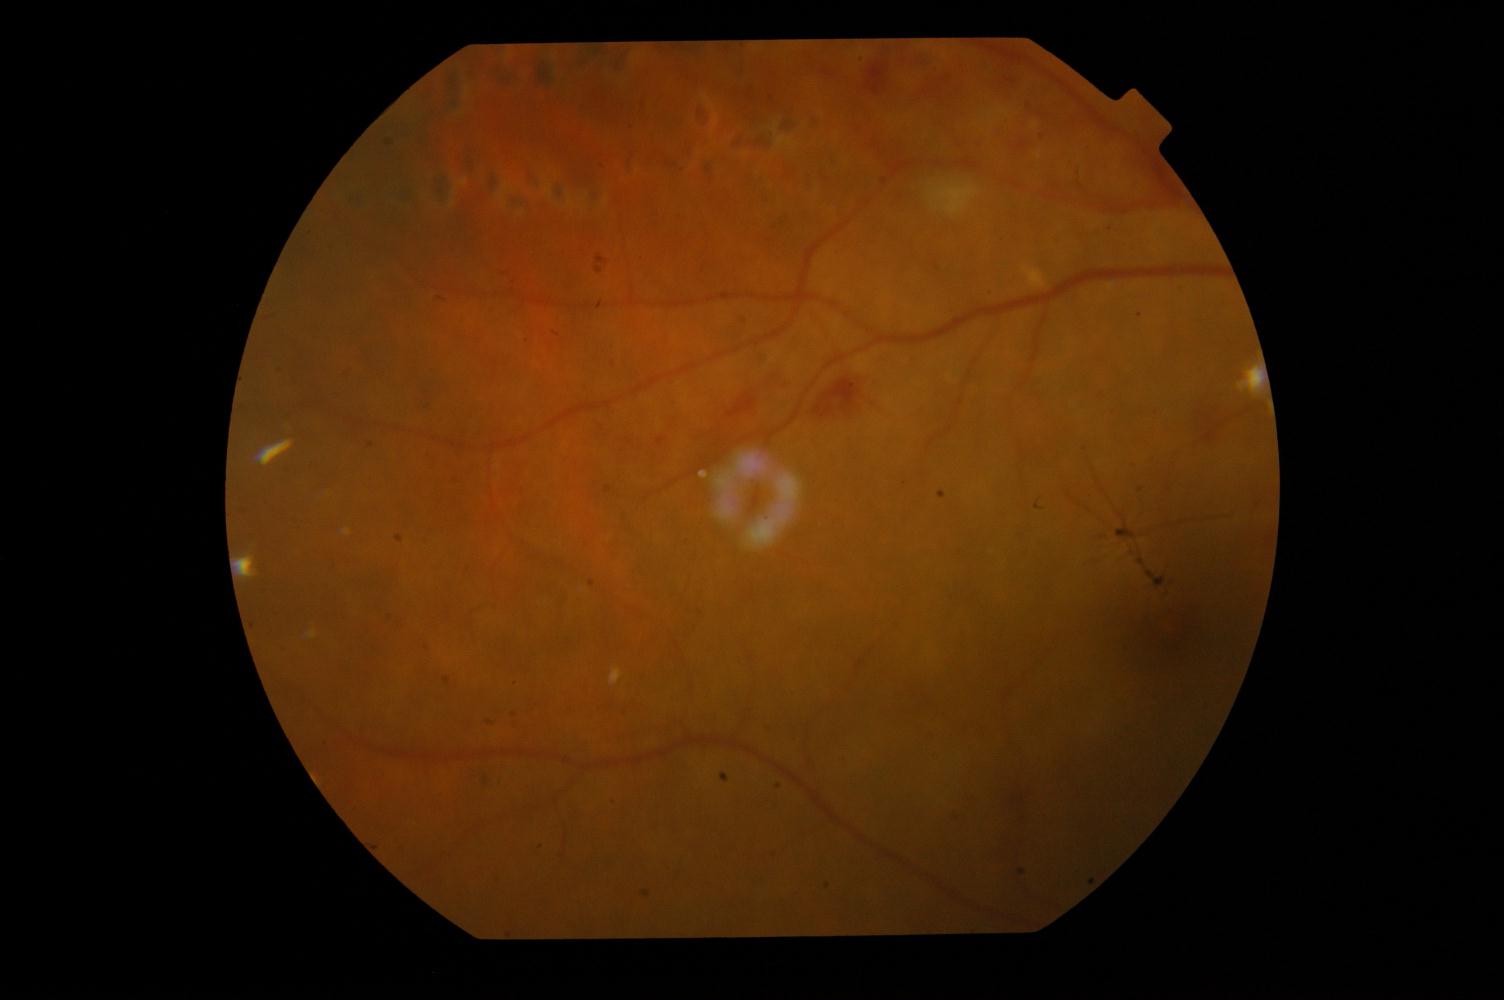

Findings: DR (diabetic retinopathy).